45° field of view; posterior pole photograph; NIDEK AFC-230; 848 by 848 pixels:
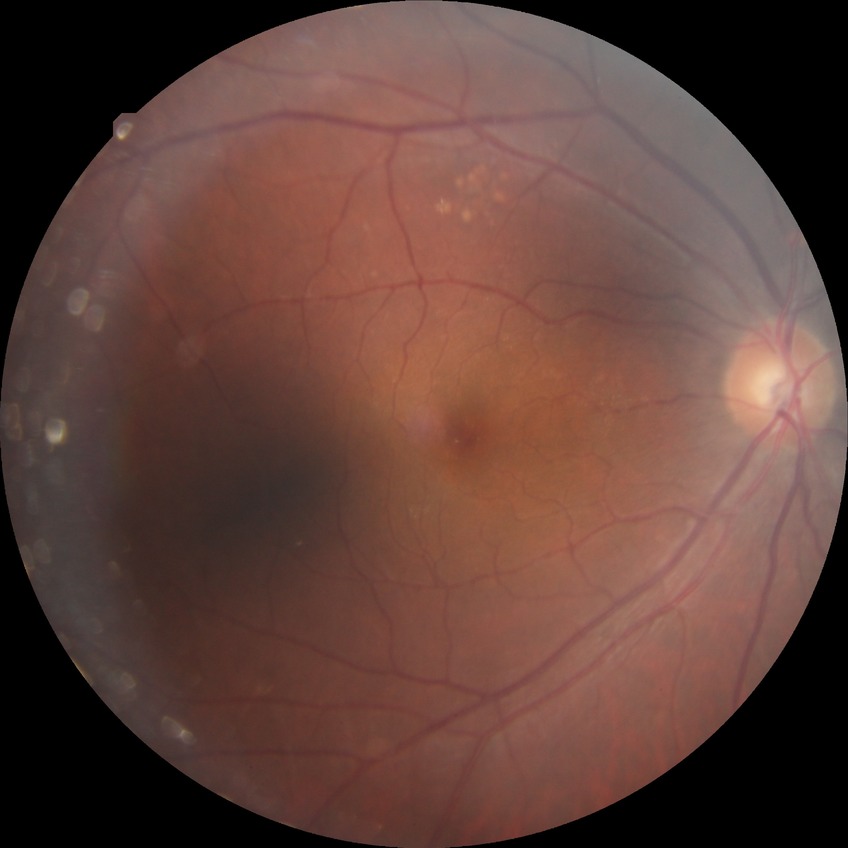 diabetic retinopathy stage=no diabetic retinopathy.